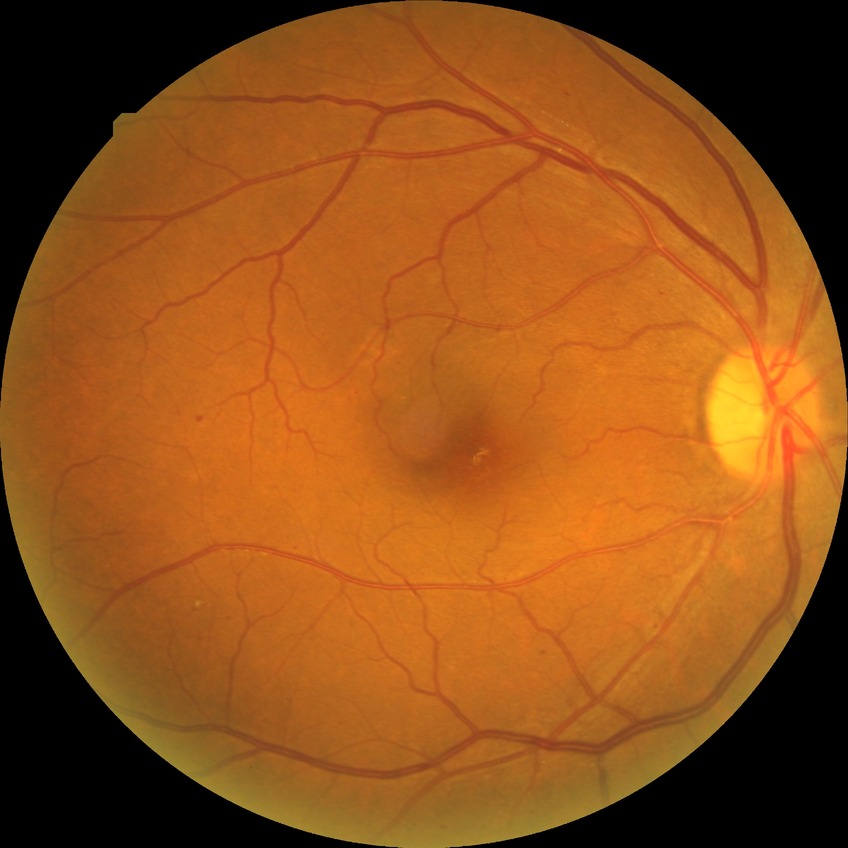

Retinopathy grade: simple diabetic retinopathy.